NIDEK AFC-230 fundus camera · fundus photo · 848x848.
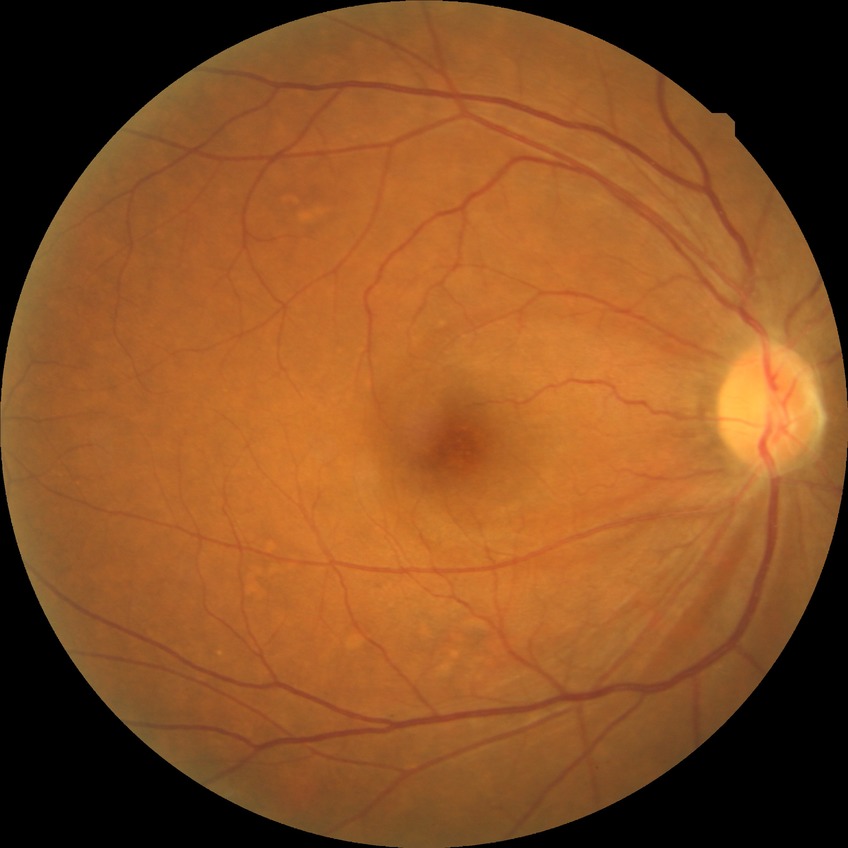
Diabetic retinopathy (DR): NDR (no diabetic retinopathy).